FOV: 45 degrees, posterior pole photograph: 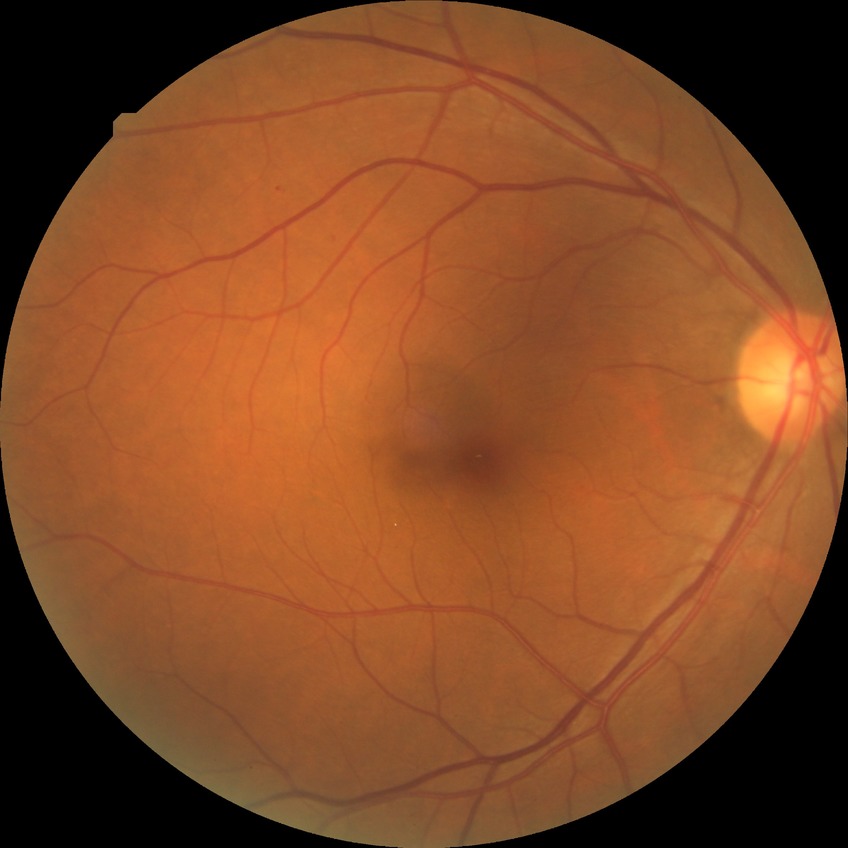
diabetic retinopathy (DR)@simple diabetic retinopathy (SDR).